Color fundus image, 45-degree field of view
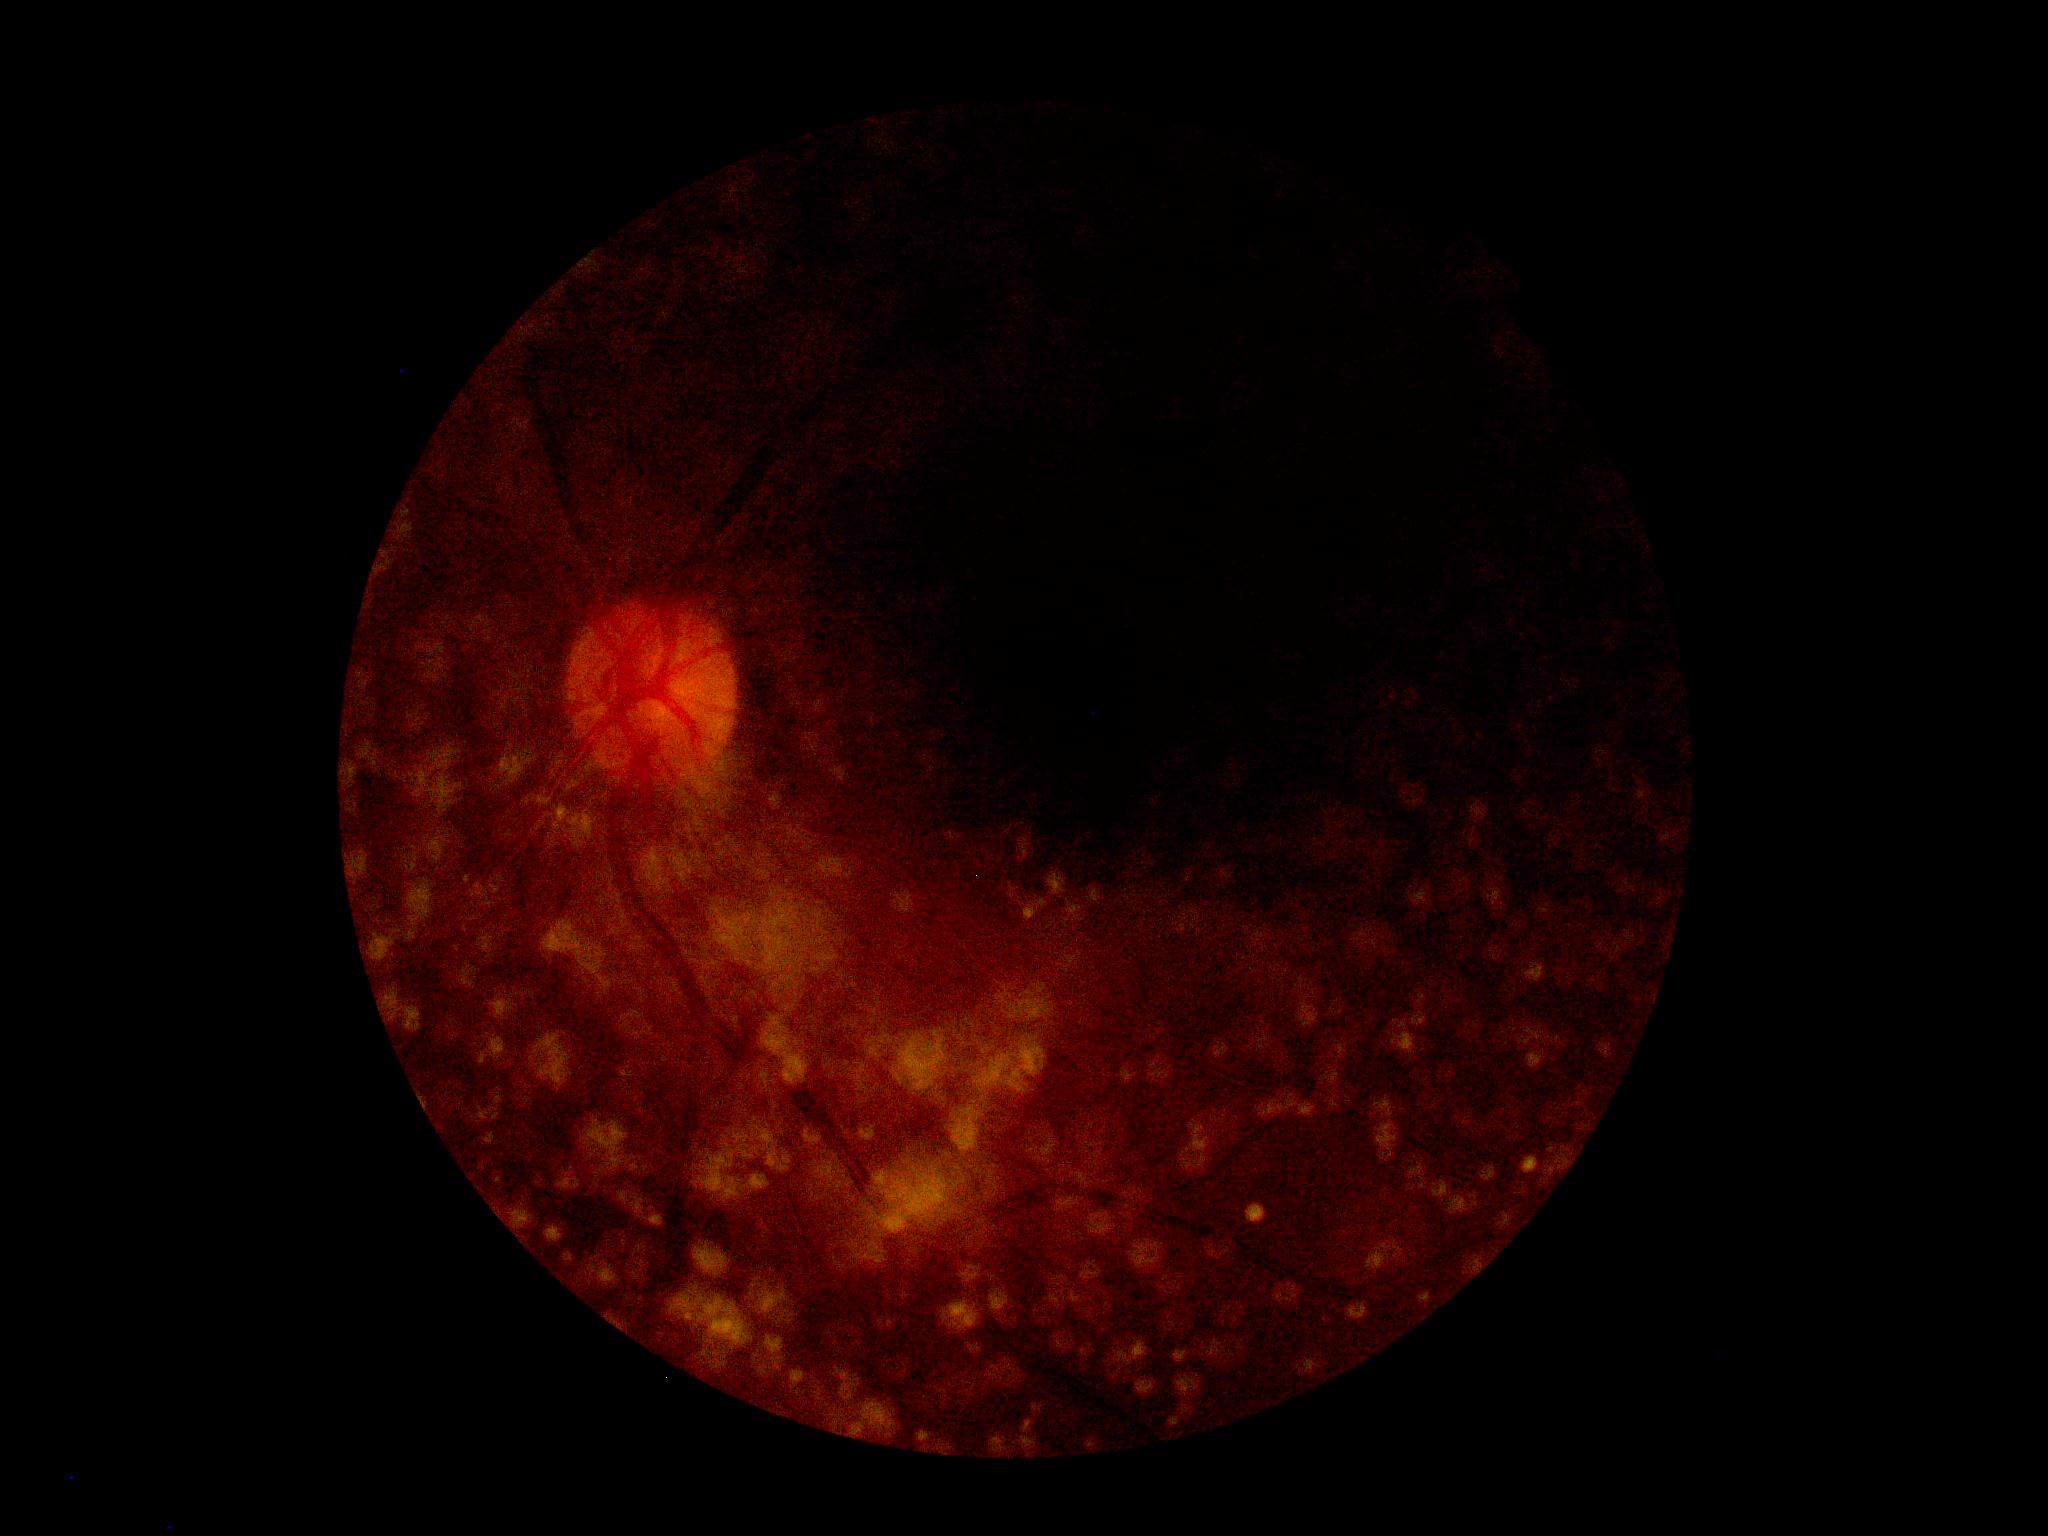

Retinopathy grade: ungradable due to poor image quality.